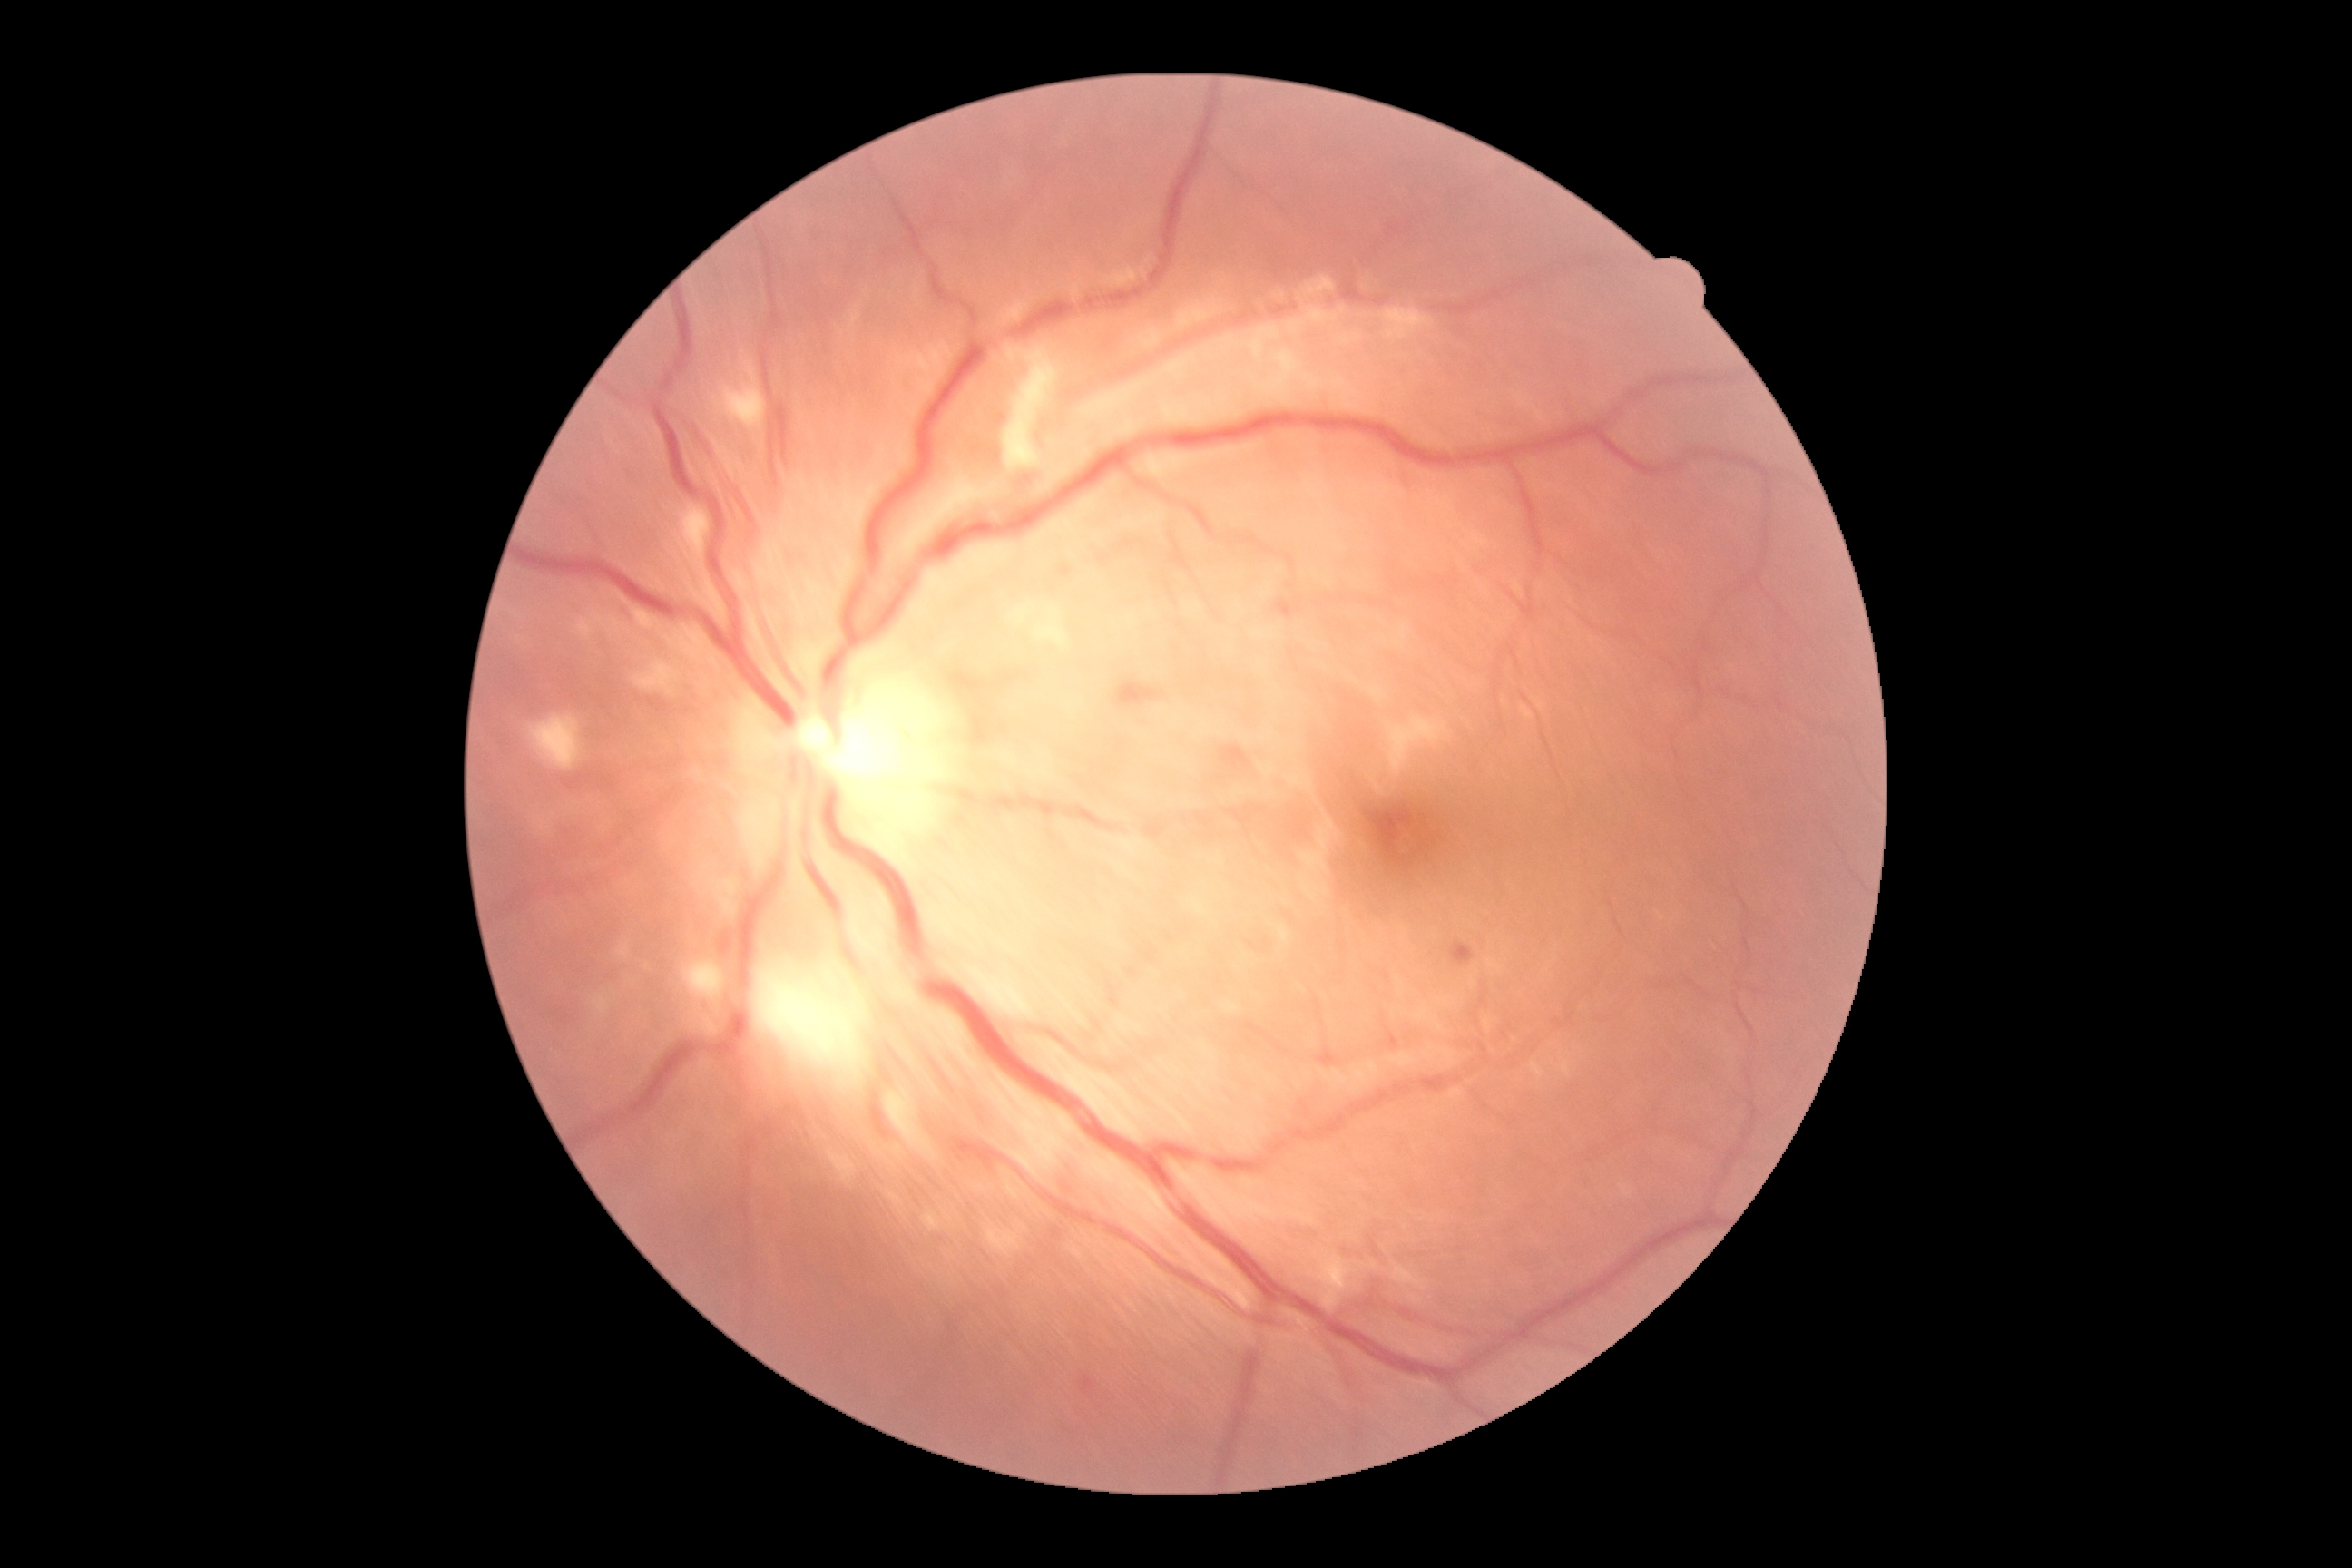 {"dr_grade": "grade 2 (moderate NPDR)"}